Wide-field fundus image from infant ROP screening
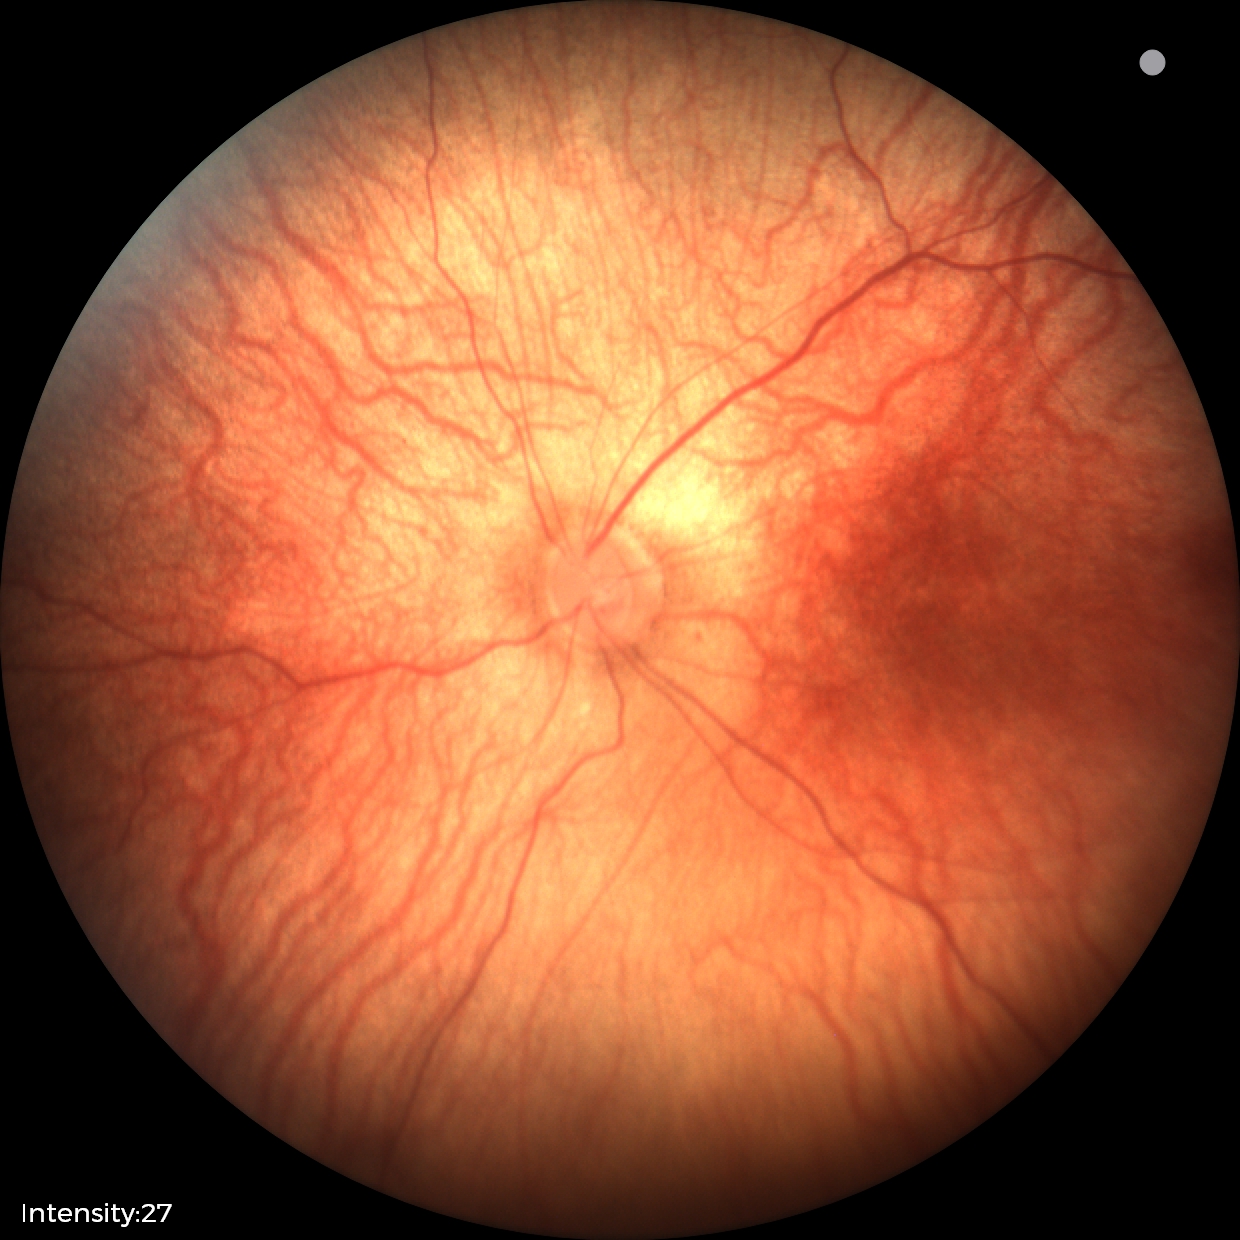

Diagnosis: no pathology identified.